FOV: 45 degrees · 2352 x 1568 pixels: 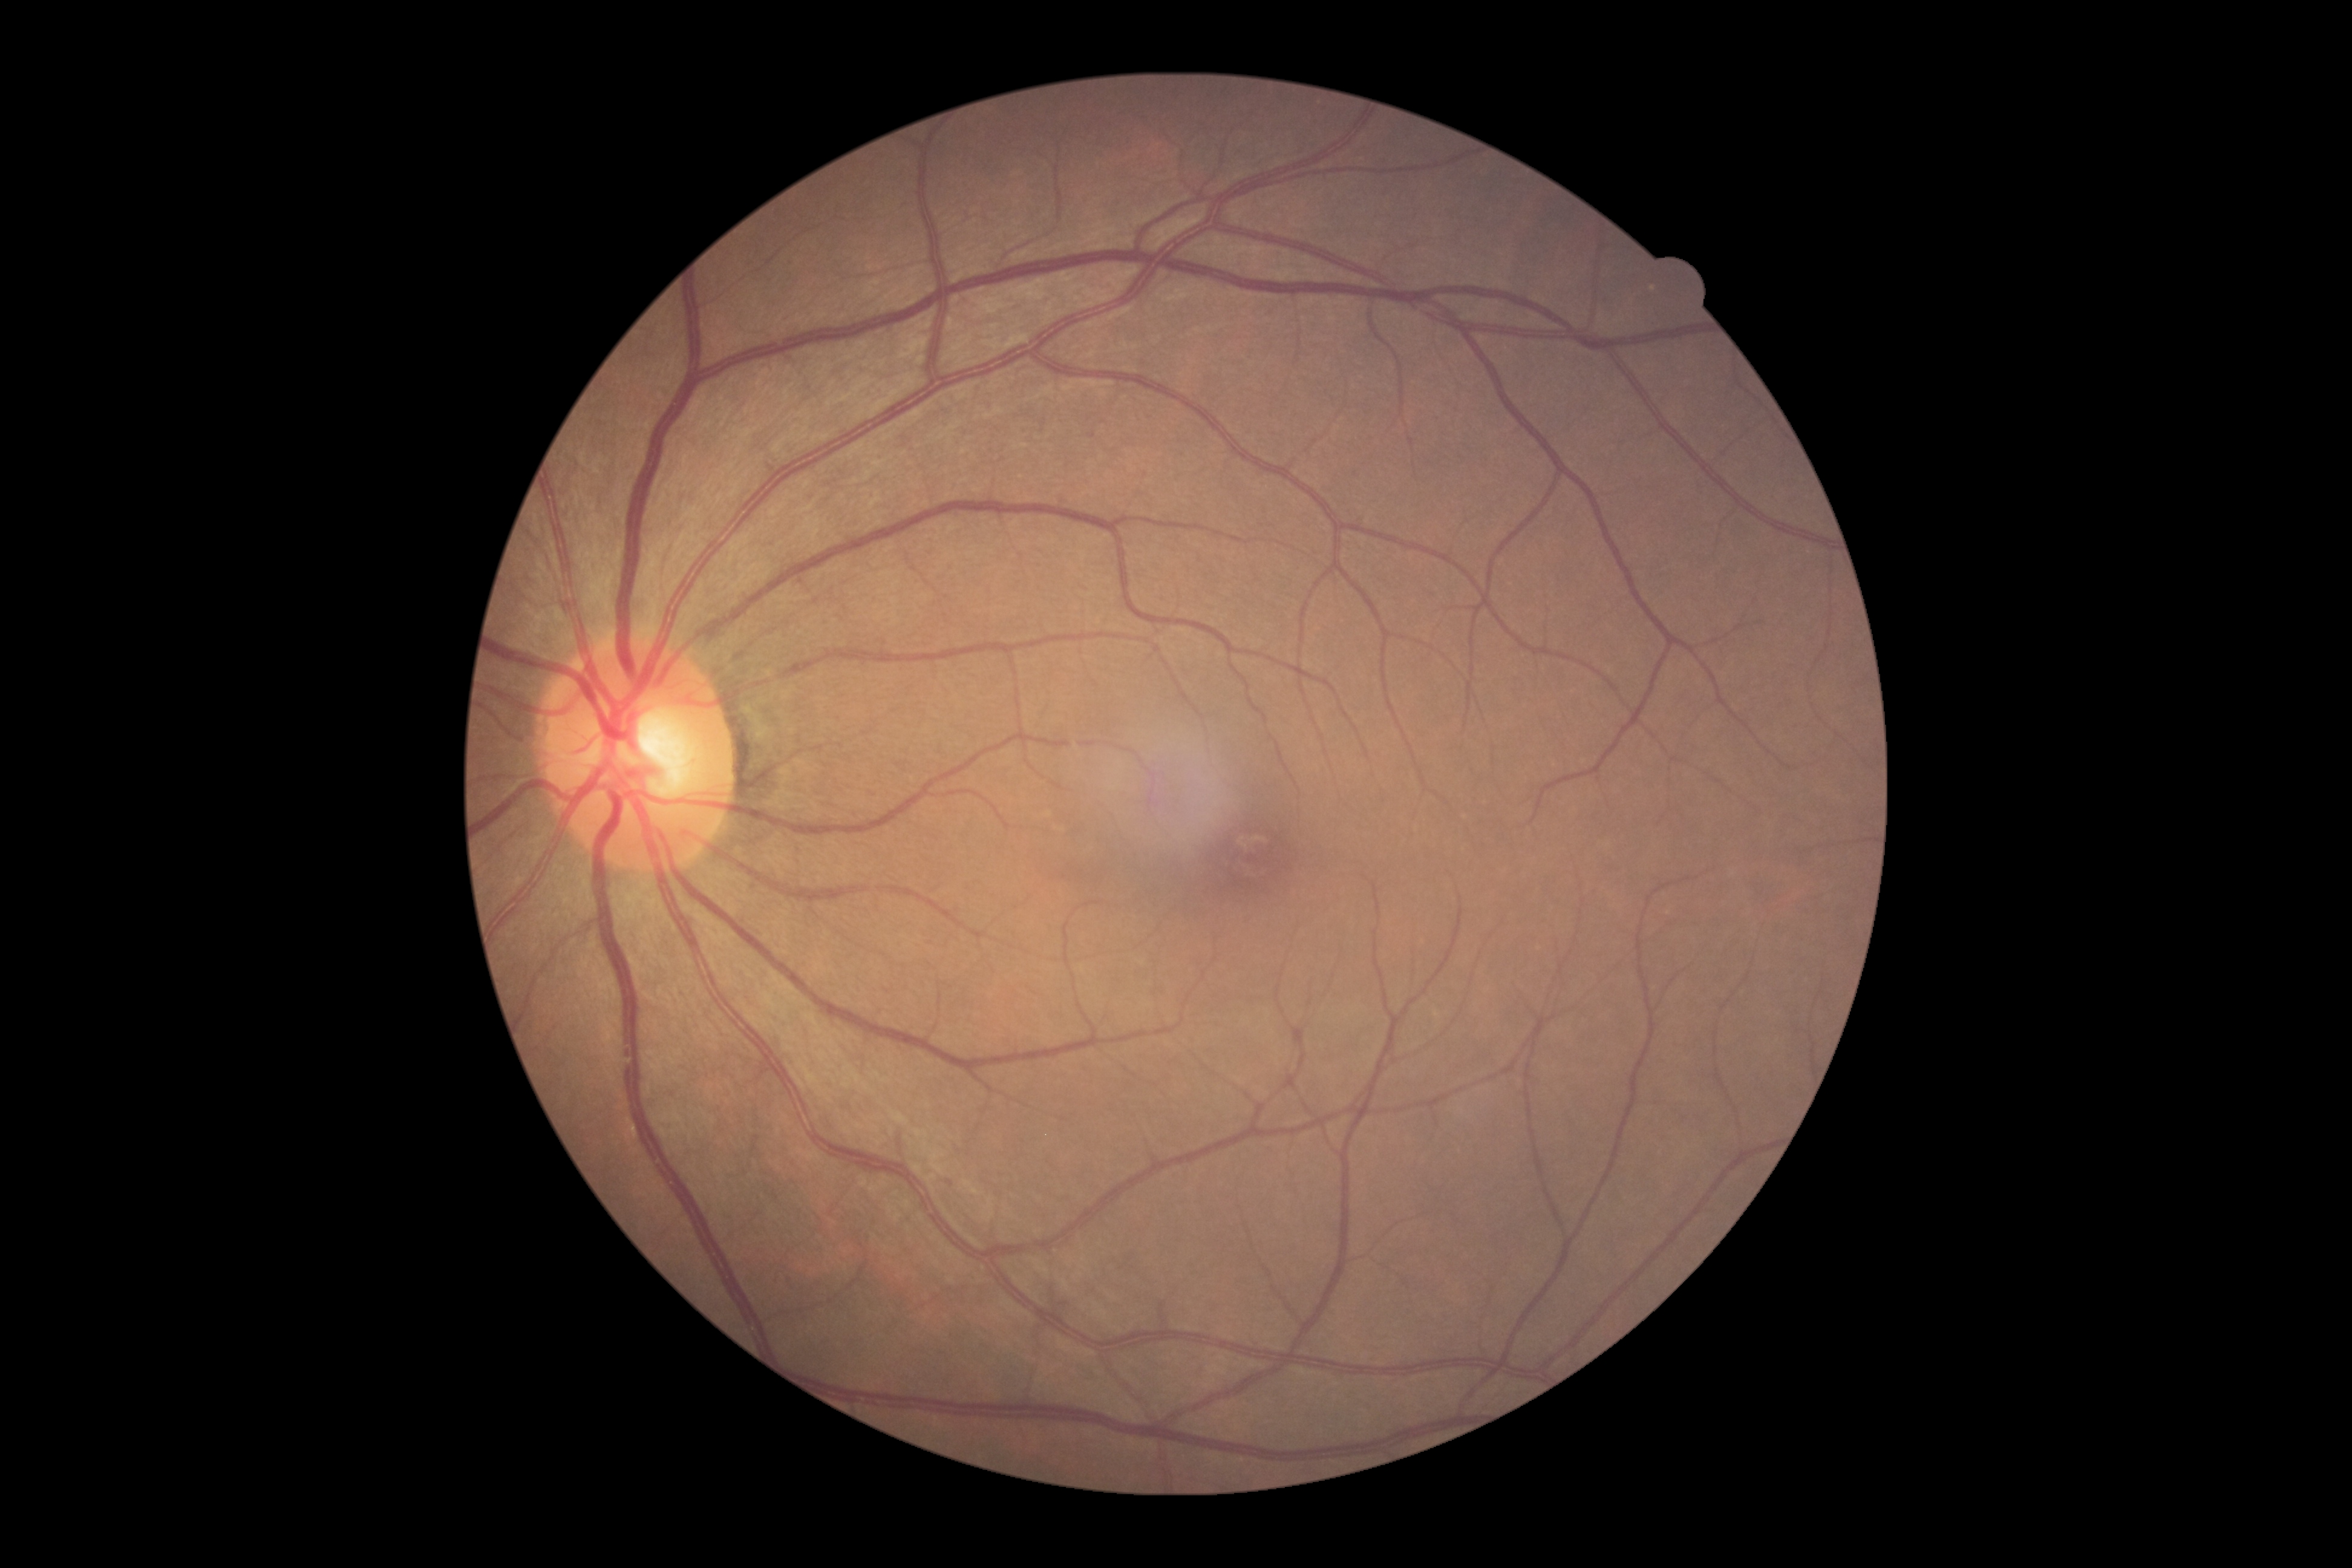

Diabetic retinopathy grade: 0.